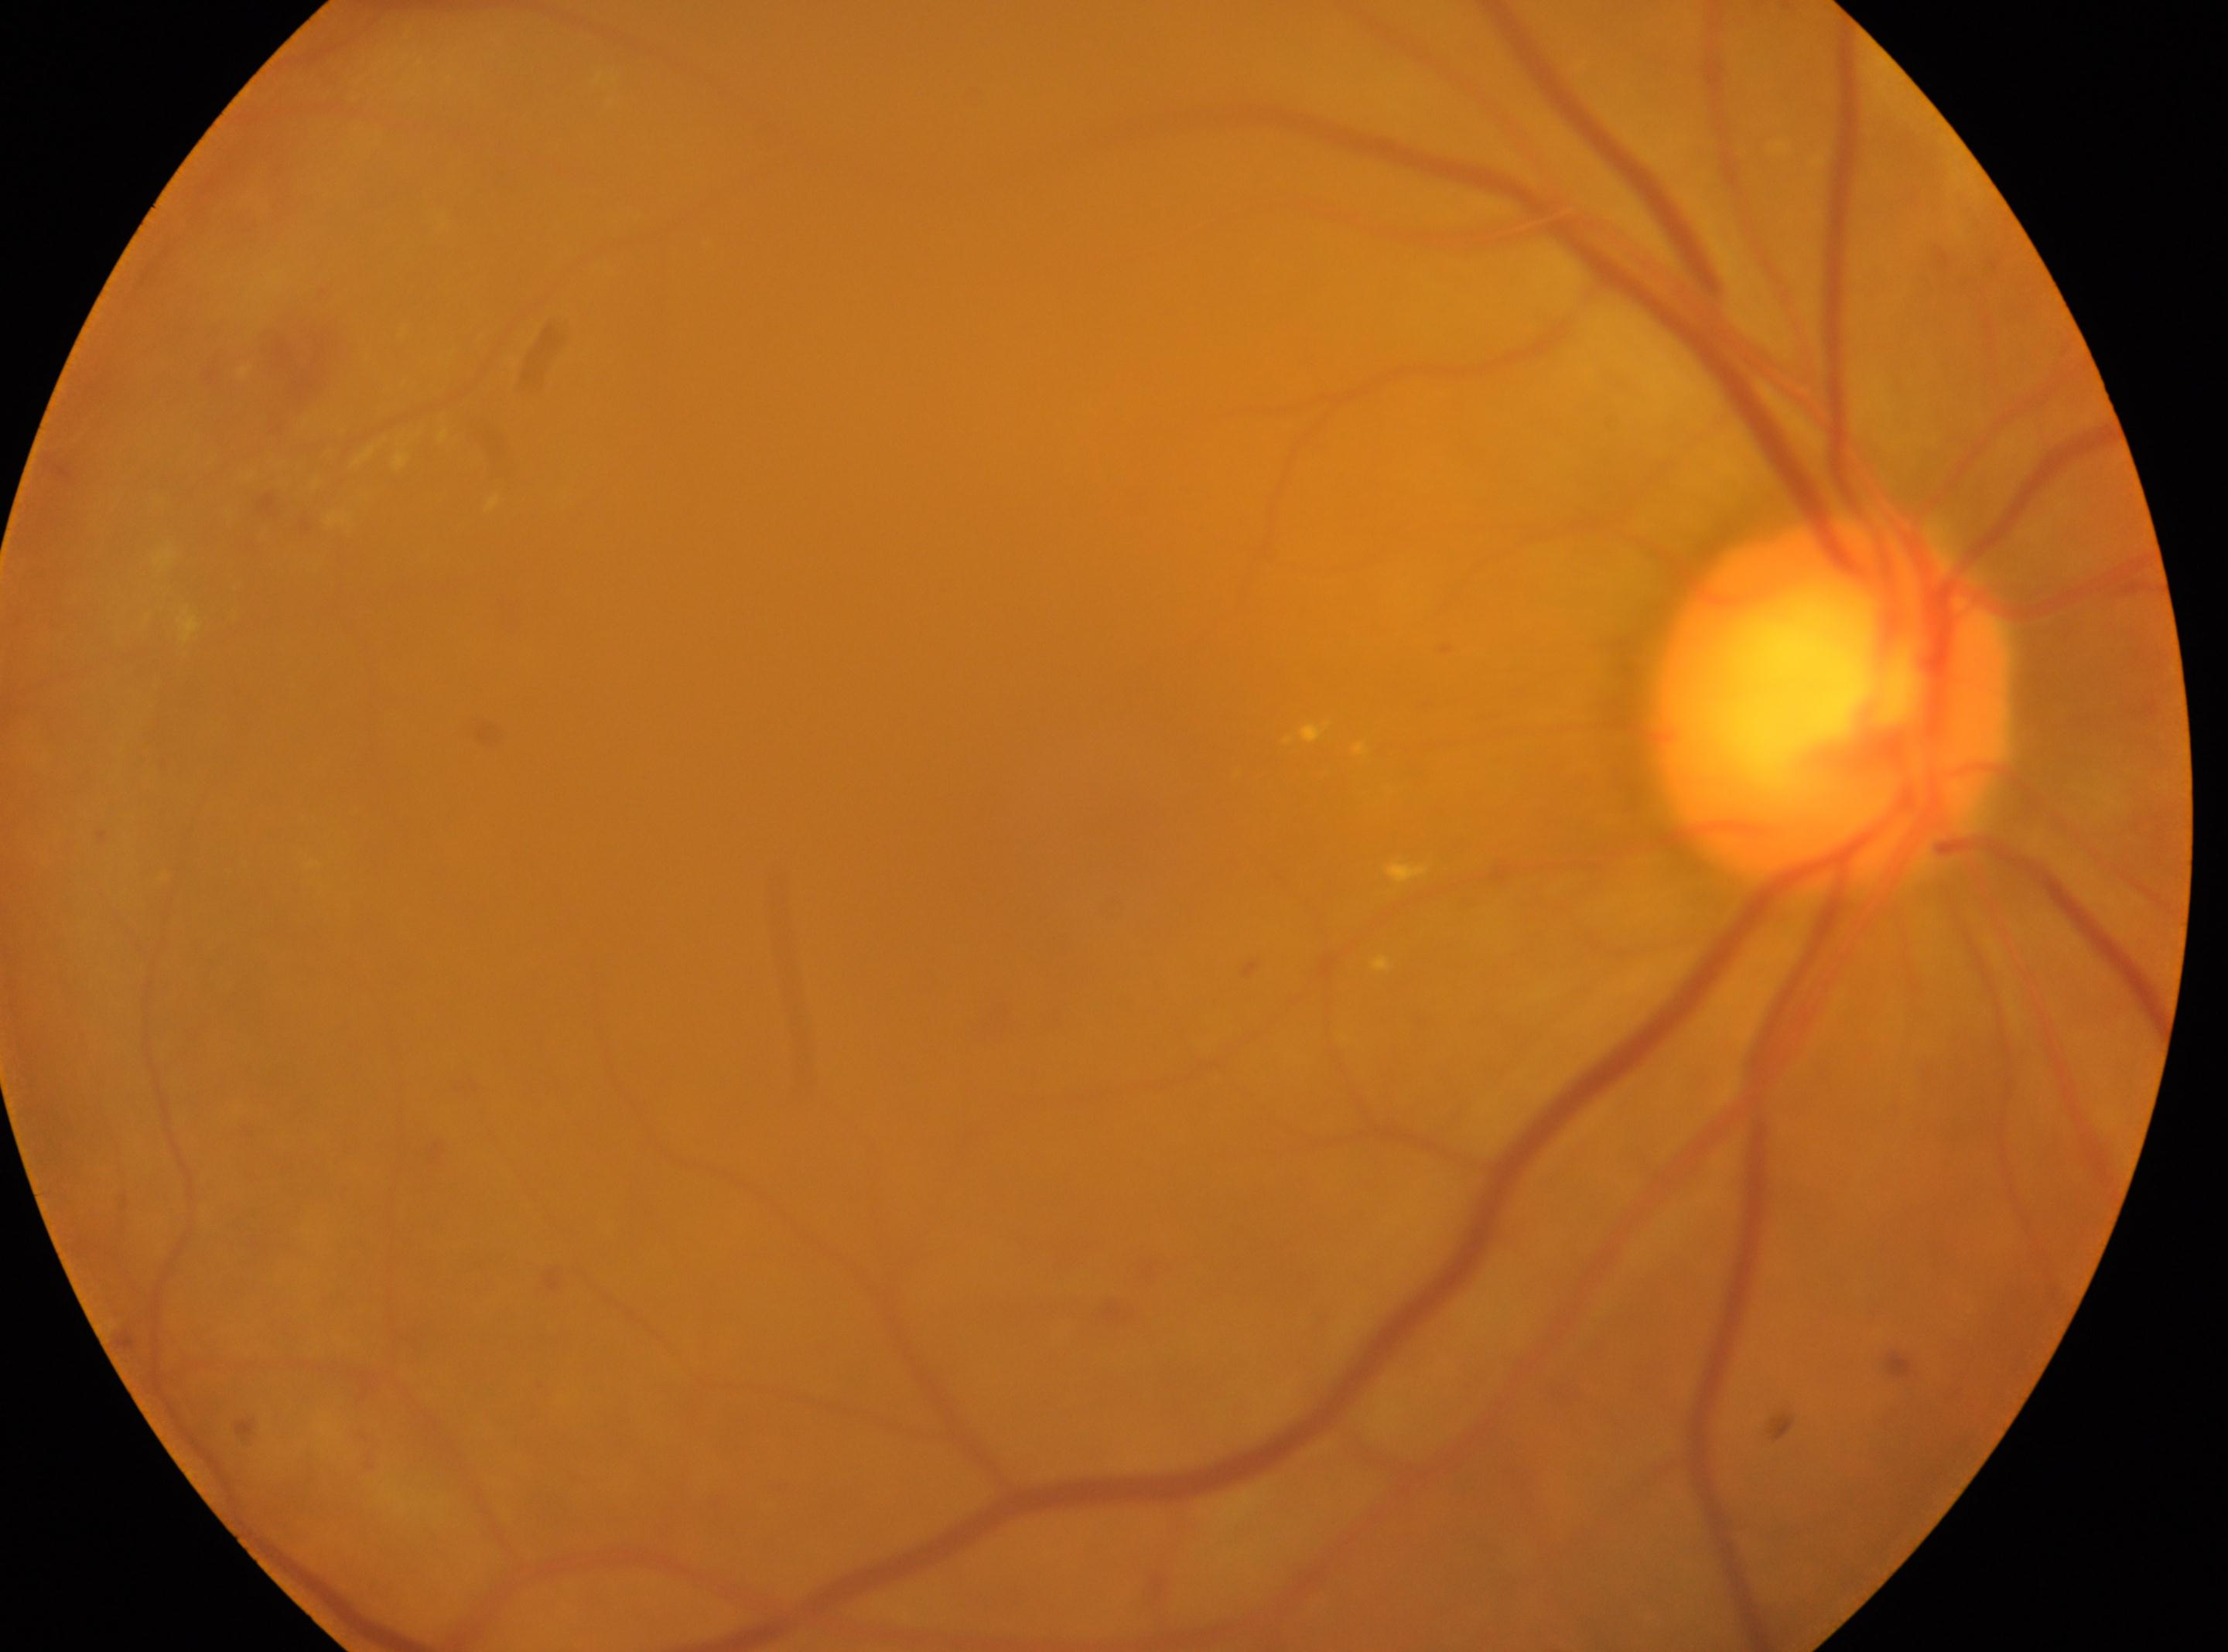

optic disk = (1830,698), laterality = right, DR stage = 2/4, fovea centralis = (1032,792).